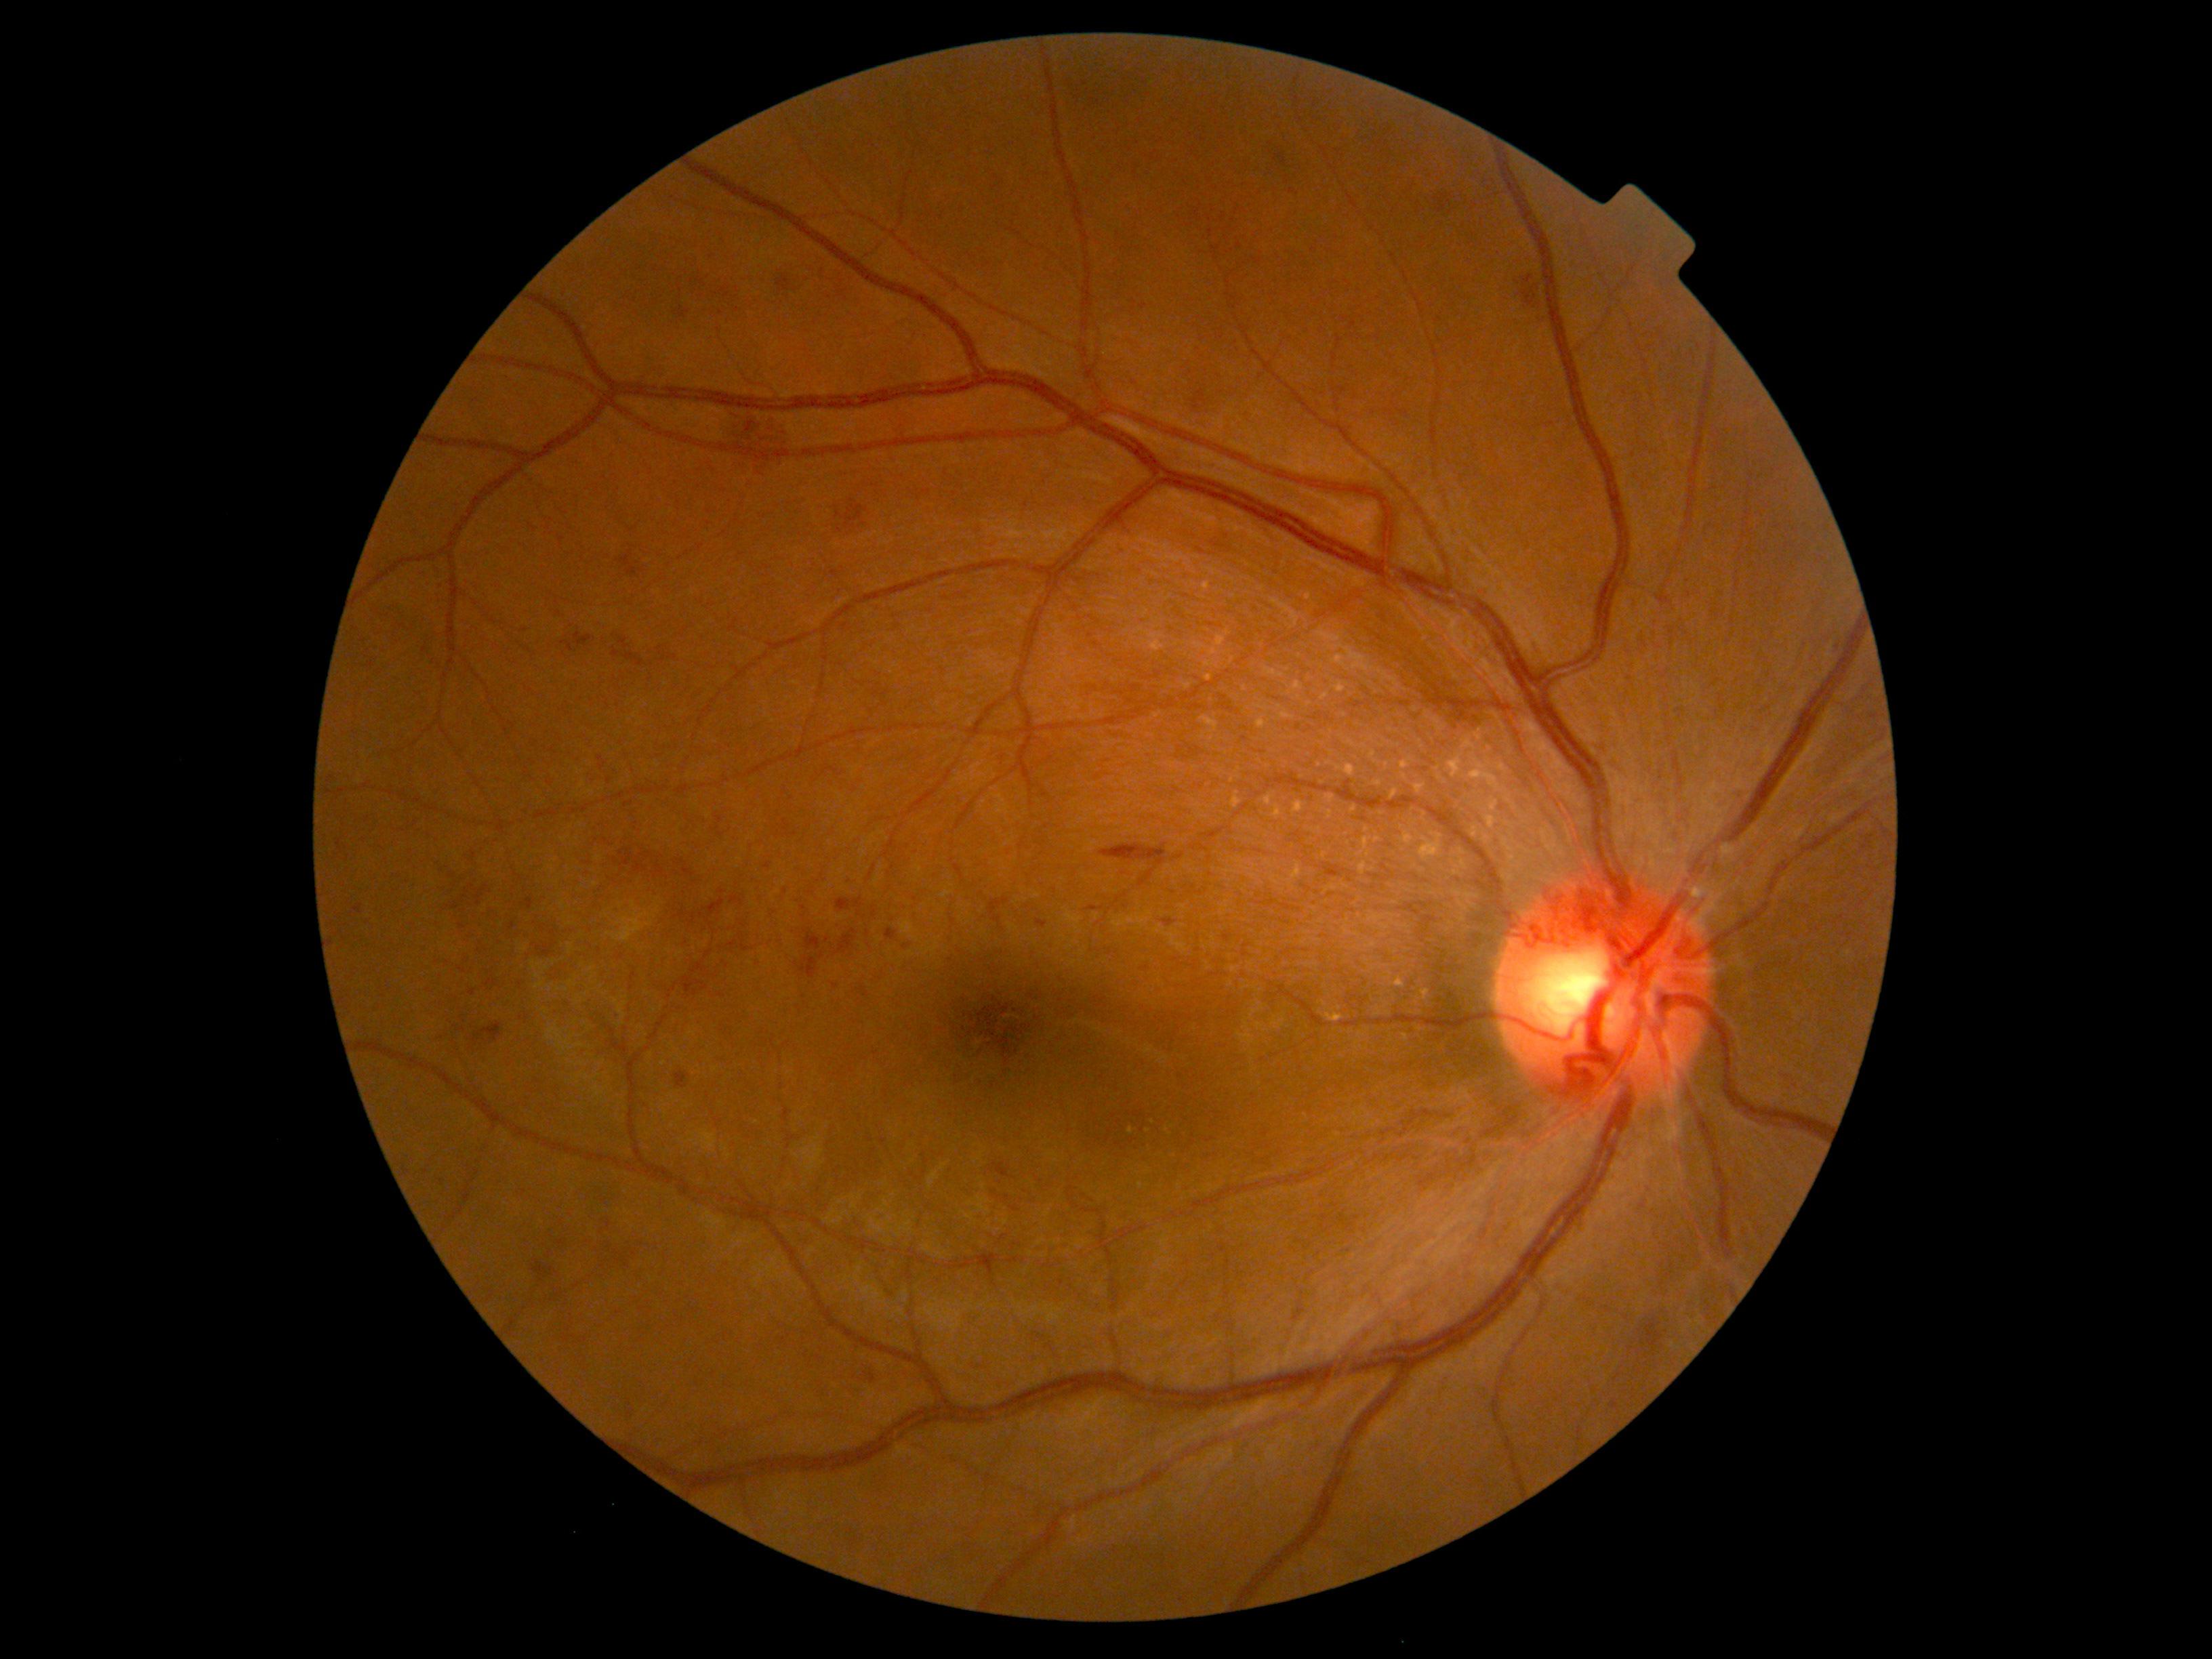
Diabetic retinopathy (DR) is grade 2. Hemorrhages (HEs) are present, including at <region>989, 898, 1009, 928</region>; <region>1646, 1185, 1653, 1195</region>; <region>829, 495, 871, 537</region>; <region>682, 978, 708, 996</region>; <region>523, 898, 533, 909</region>; <region>1038, 920, 1048, 928</region>; <region>462, 890, 468, 903</region>; <region>1193, 391, 1206, 410</region>; <region>1482, 180, 1501, 197</region>; <region>619, 636, 630, 650</region>; <region>674, 1071, 691, 1089</region>. HEs (small, approximate centers) near <point>455, 906</point>; <point>663, 660</point>; <point>908, 846</point>; <point>453, 876</point>; <point>1144, 306</point>; <point>1292, 191</point>; <point>686, 630</point>.